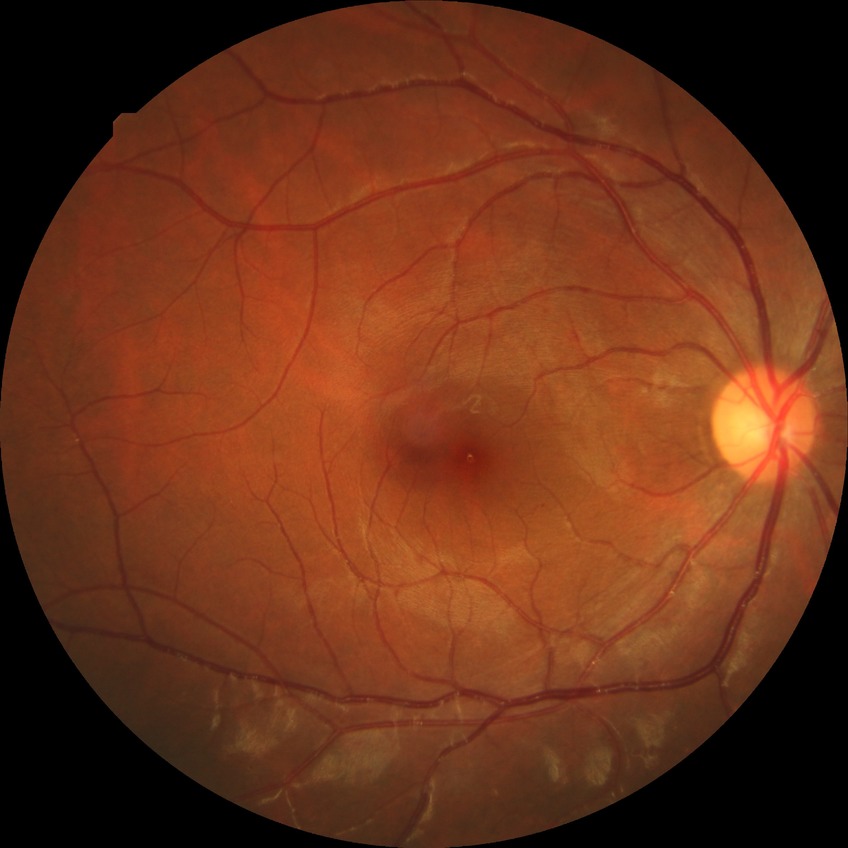
Diabetic retinopathy (DR): SDR (simple diabetic retinopathy).